Color fundus image, image size 2346x1568, 45-degree field of view: 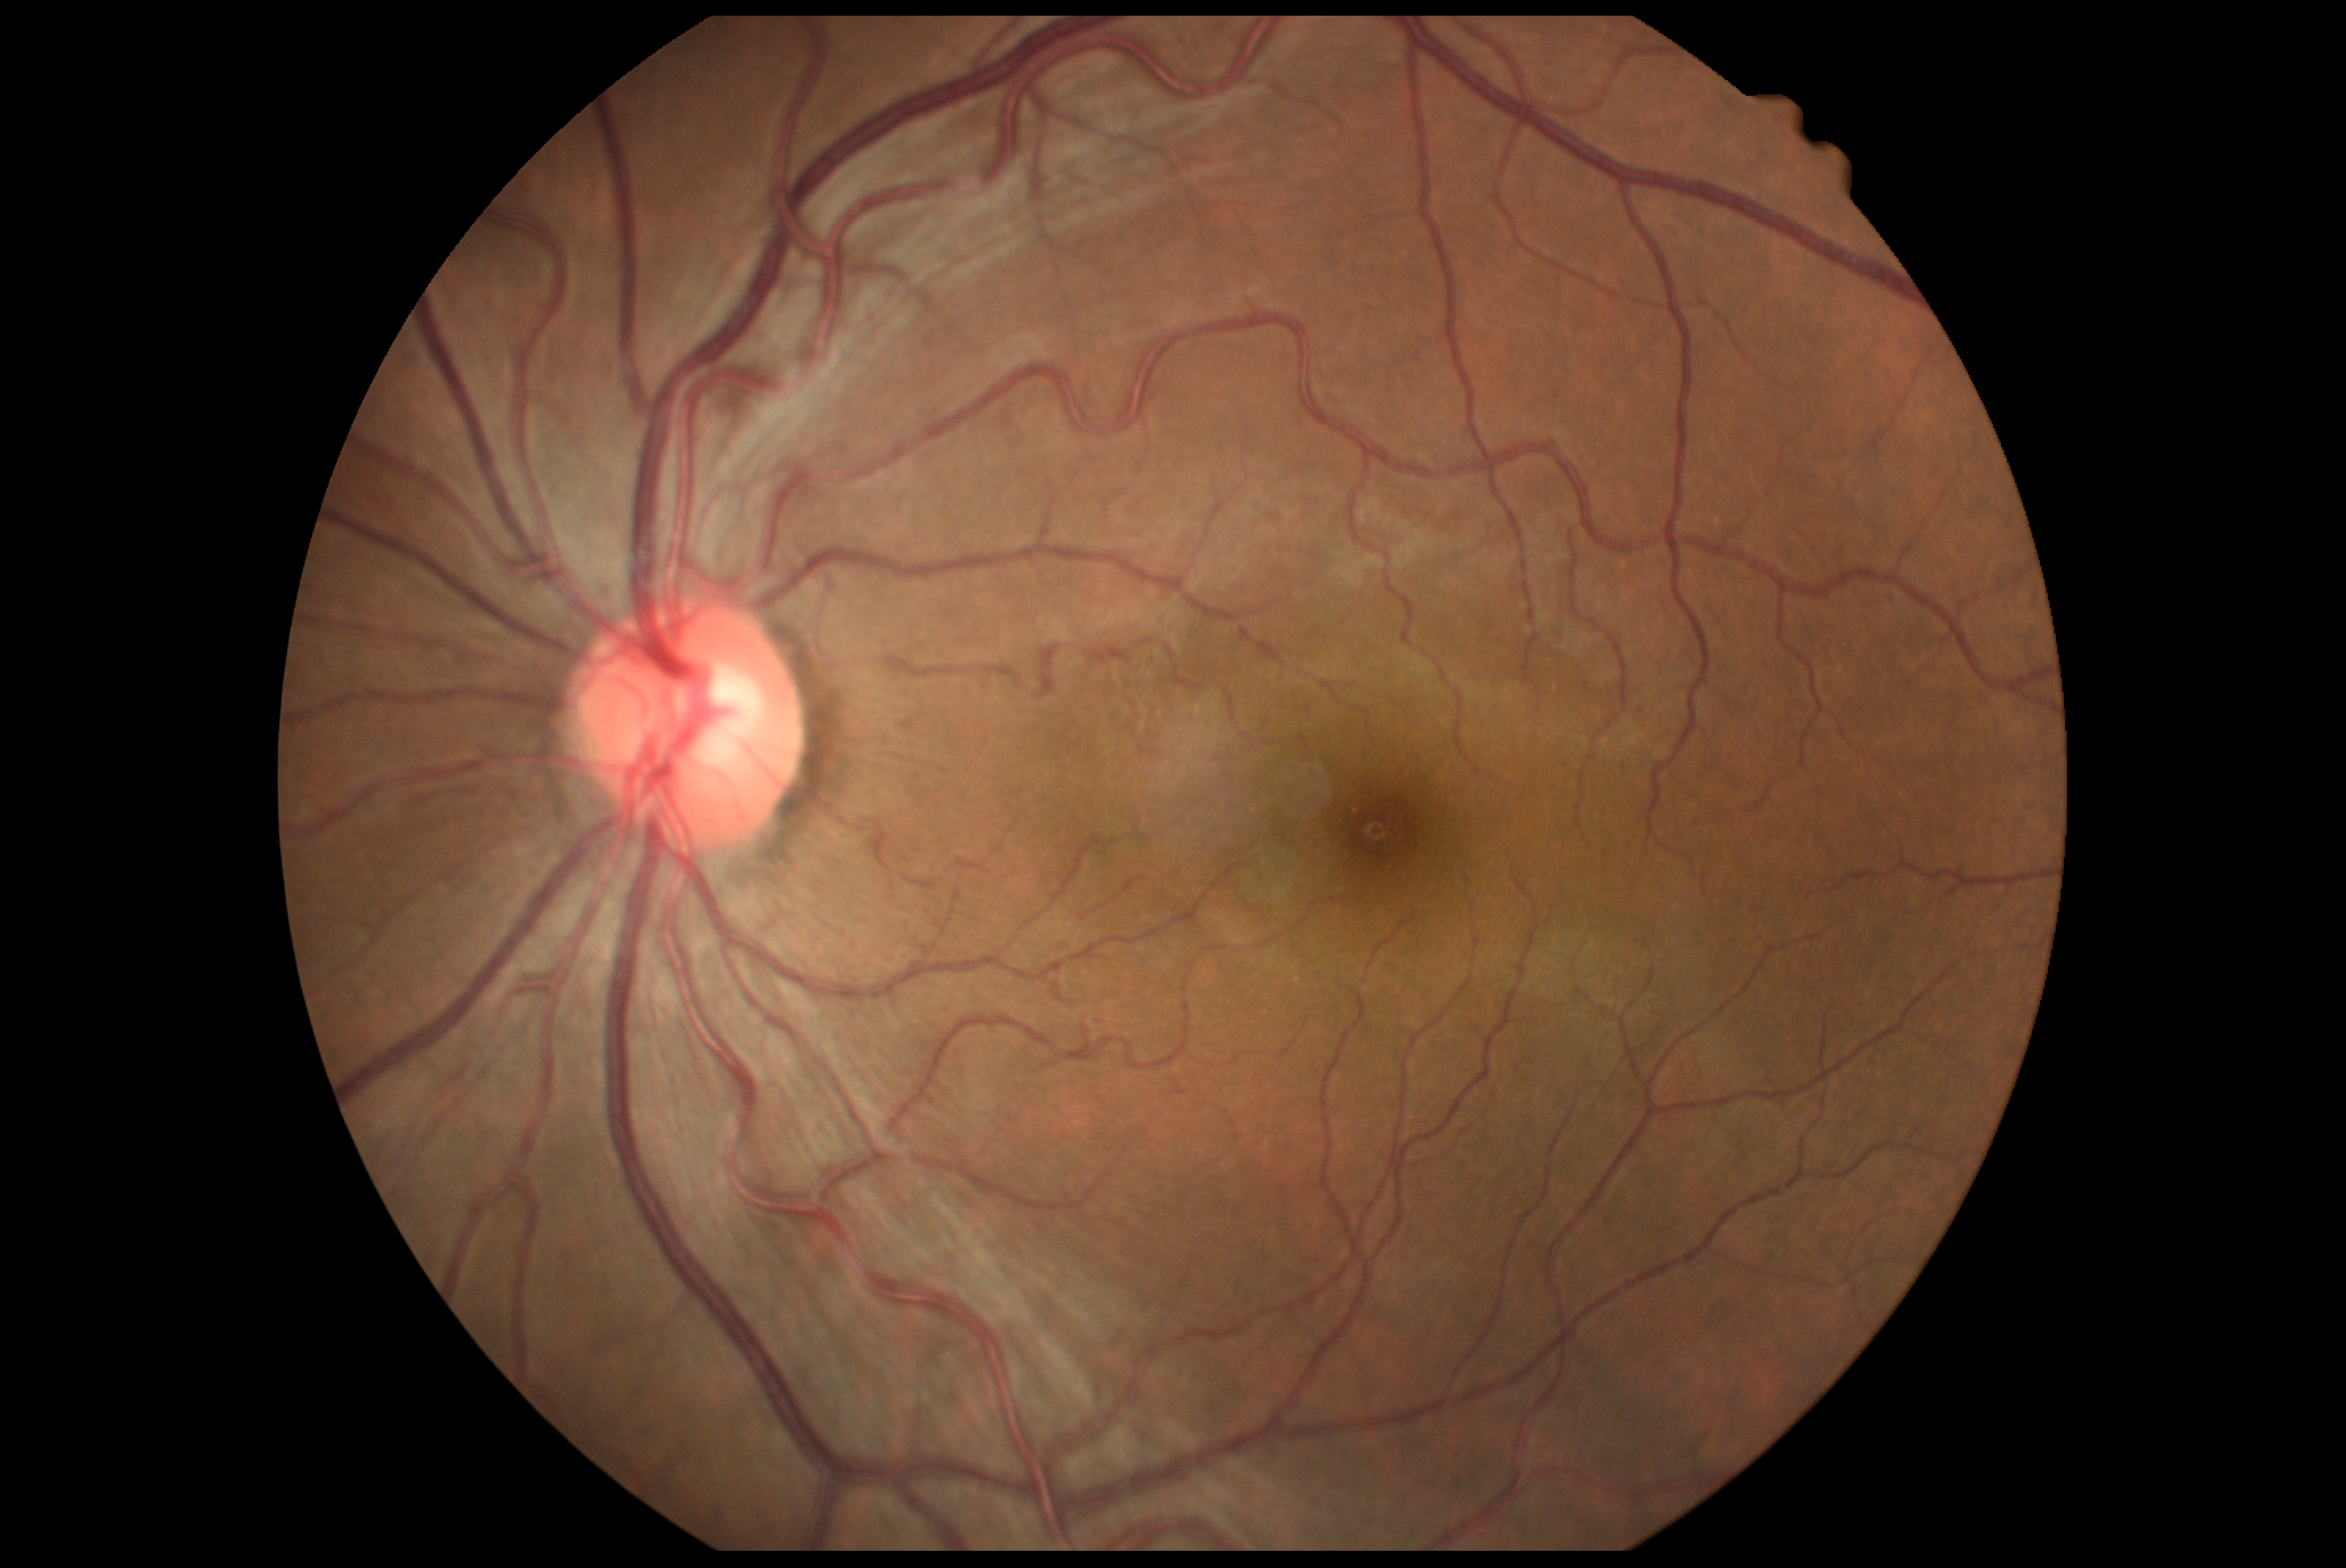

- DR grade — 0 (no apparent retinopathy)
- DR impression — negative for DR